ONH-centered crop from a color fundus image: 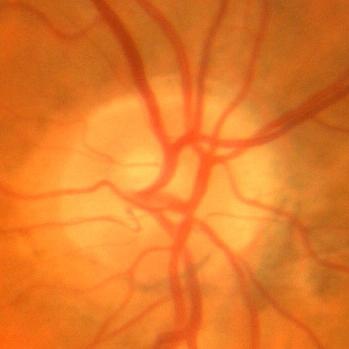 Findings consistent with no signs of glaucoma.